Camera: Nidek AFC-330.
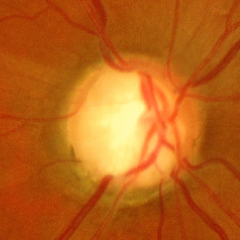 Findings consistent with glaucoma. Fundus appearance consistent with advanced glaucomatous optic neuropathy.